Color fundus photograph:
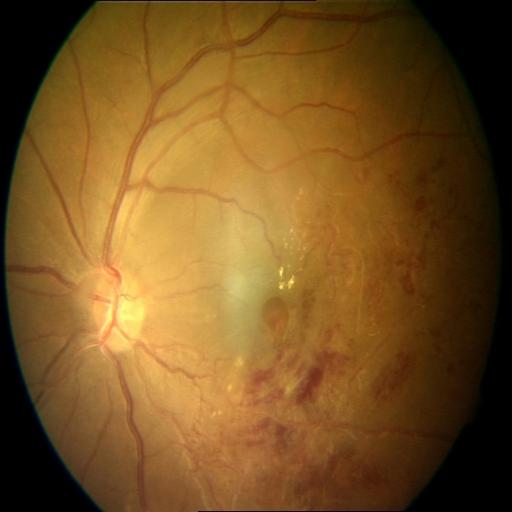

There is evidence of BRVO (branch retinal vein occlusion).